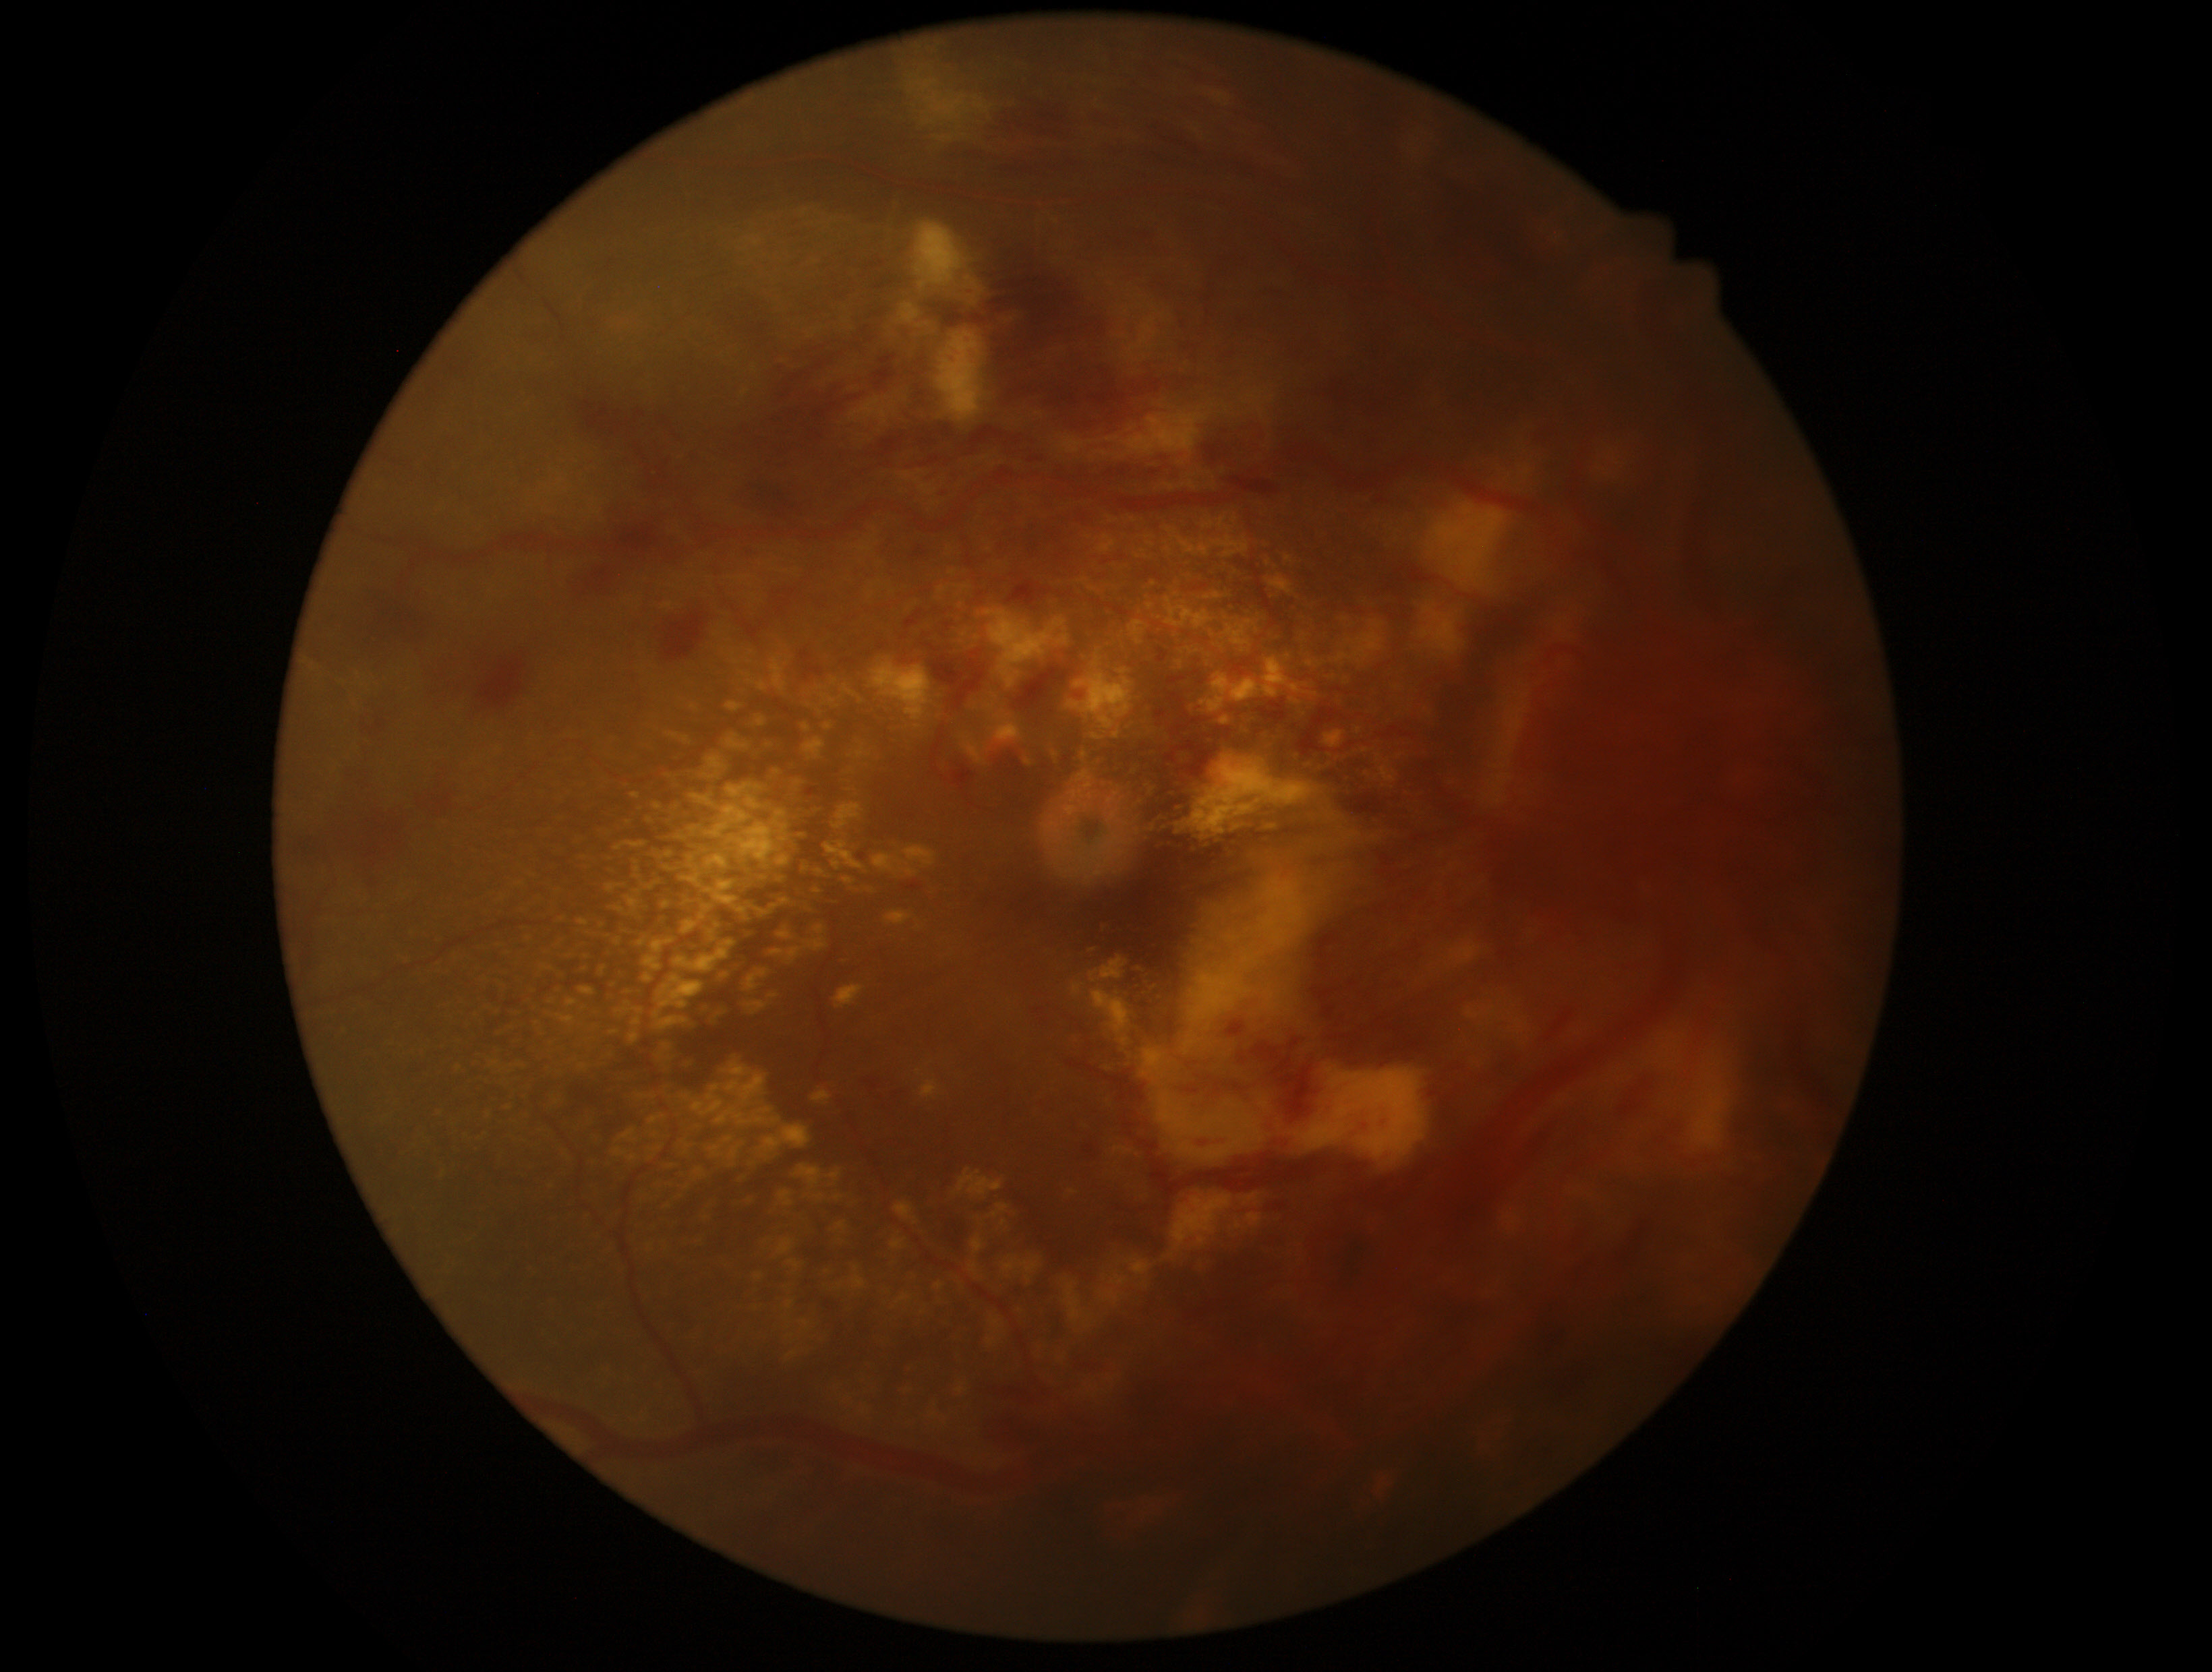

dr_grade: 4/4